Wide-field fundus photograph of an infant; image size 1240x1240.
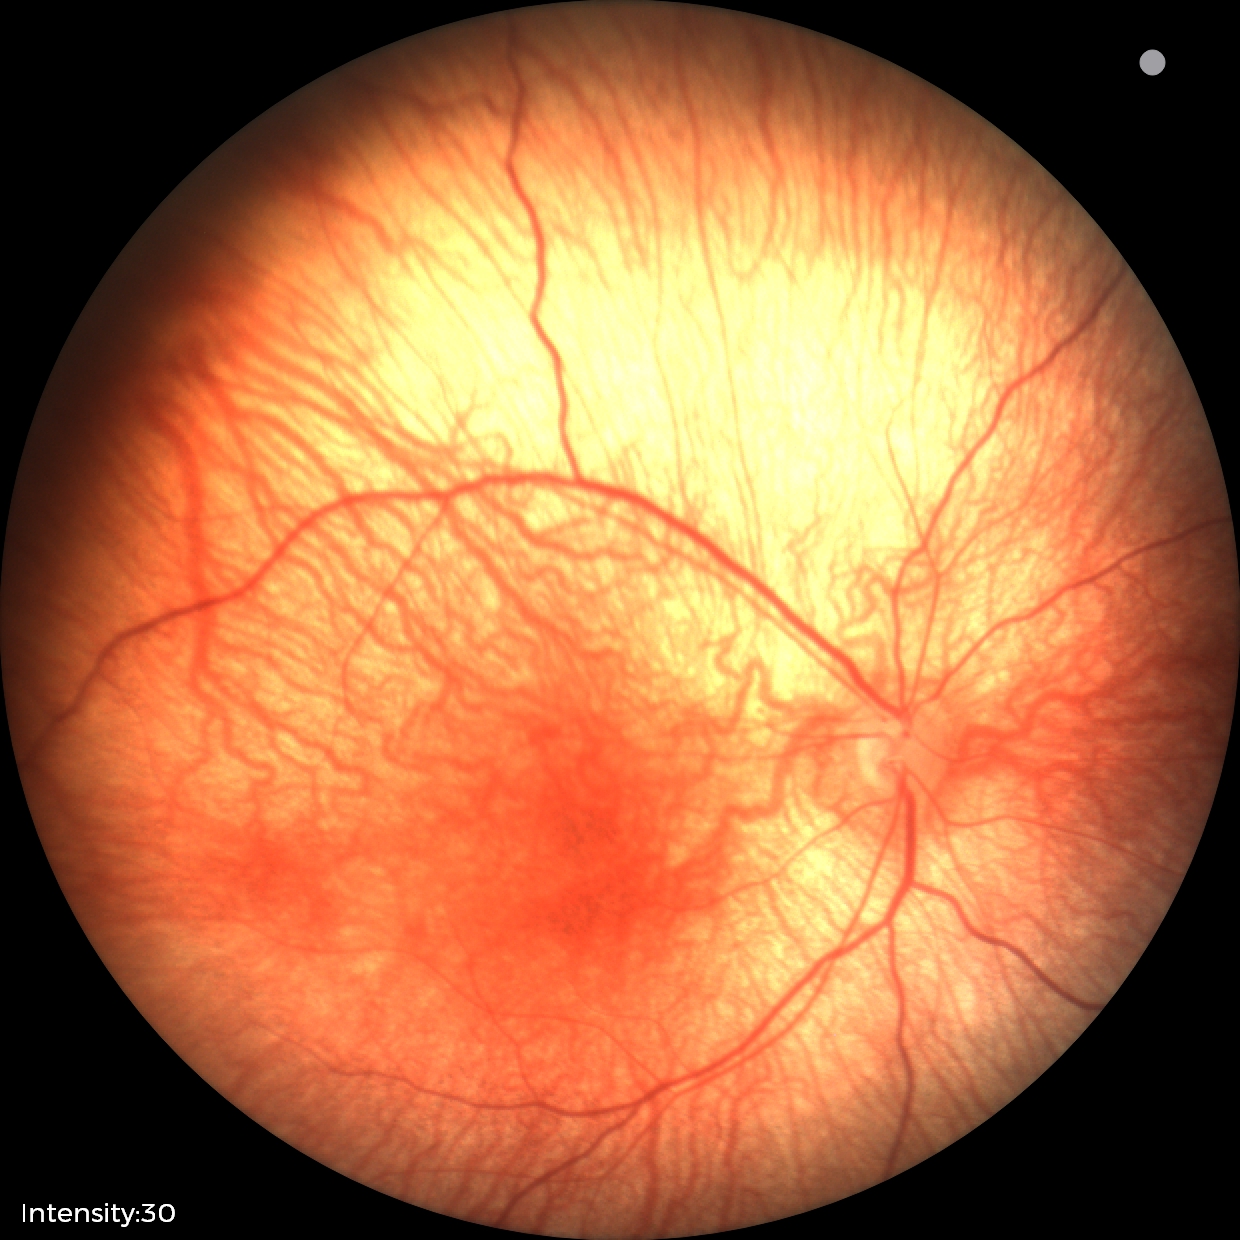 Physiological retinal appearance for postconceptual age.